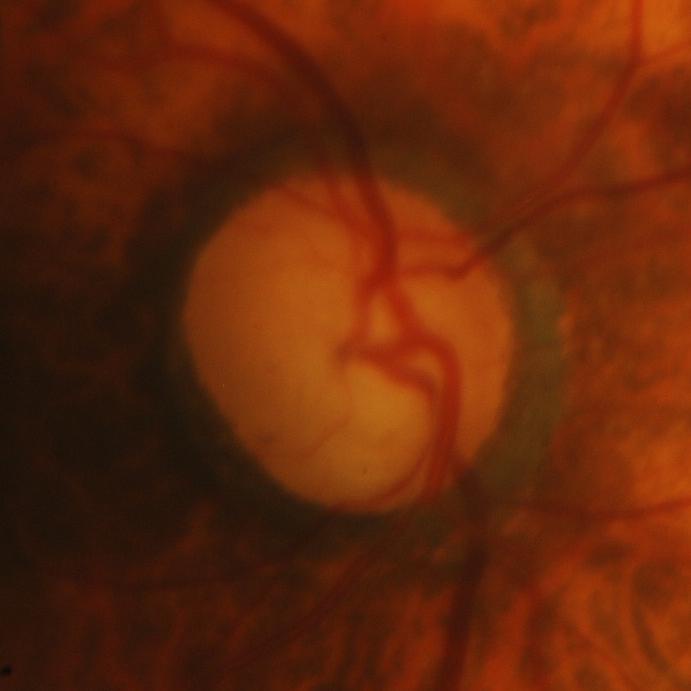

Glaucomatous changes are present. This optic disc photograph shows glaucomatous optic neuropathy.